848x848px. Graded on the modified Davis scale.
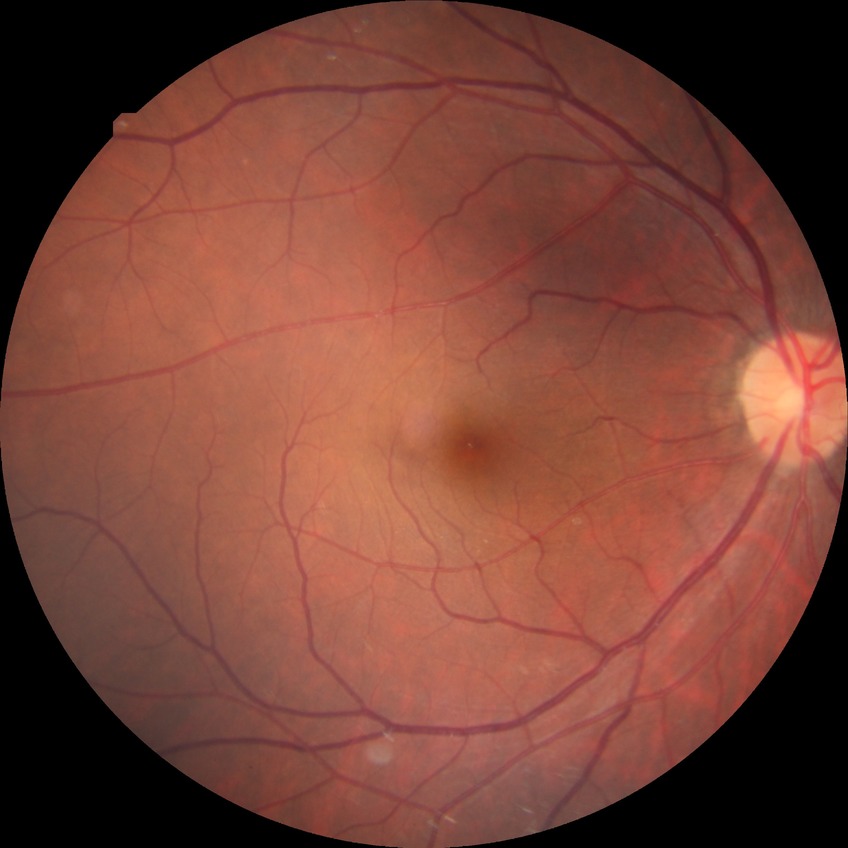
Findings:
• modified Davis classification — pre-proliferative diabetic retinopathy